Captured with the Clarity RetCam 3 (130° field of view); 640 x 480 pixels; infant wide-field fundus photograph
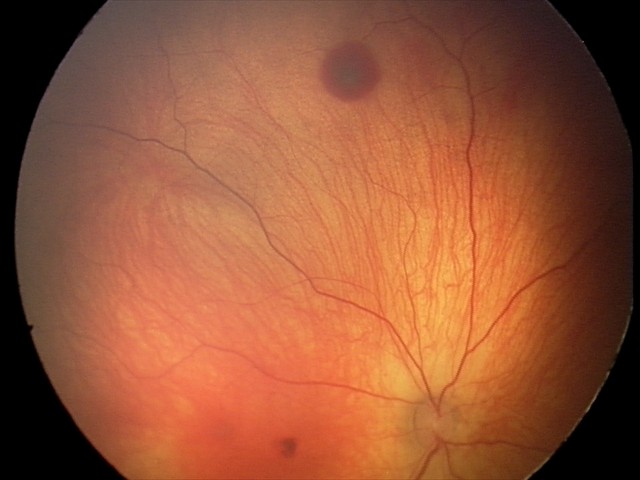

Screening series with retinal hemorrhages.